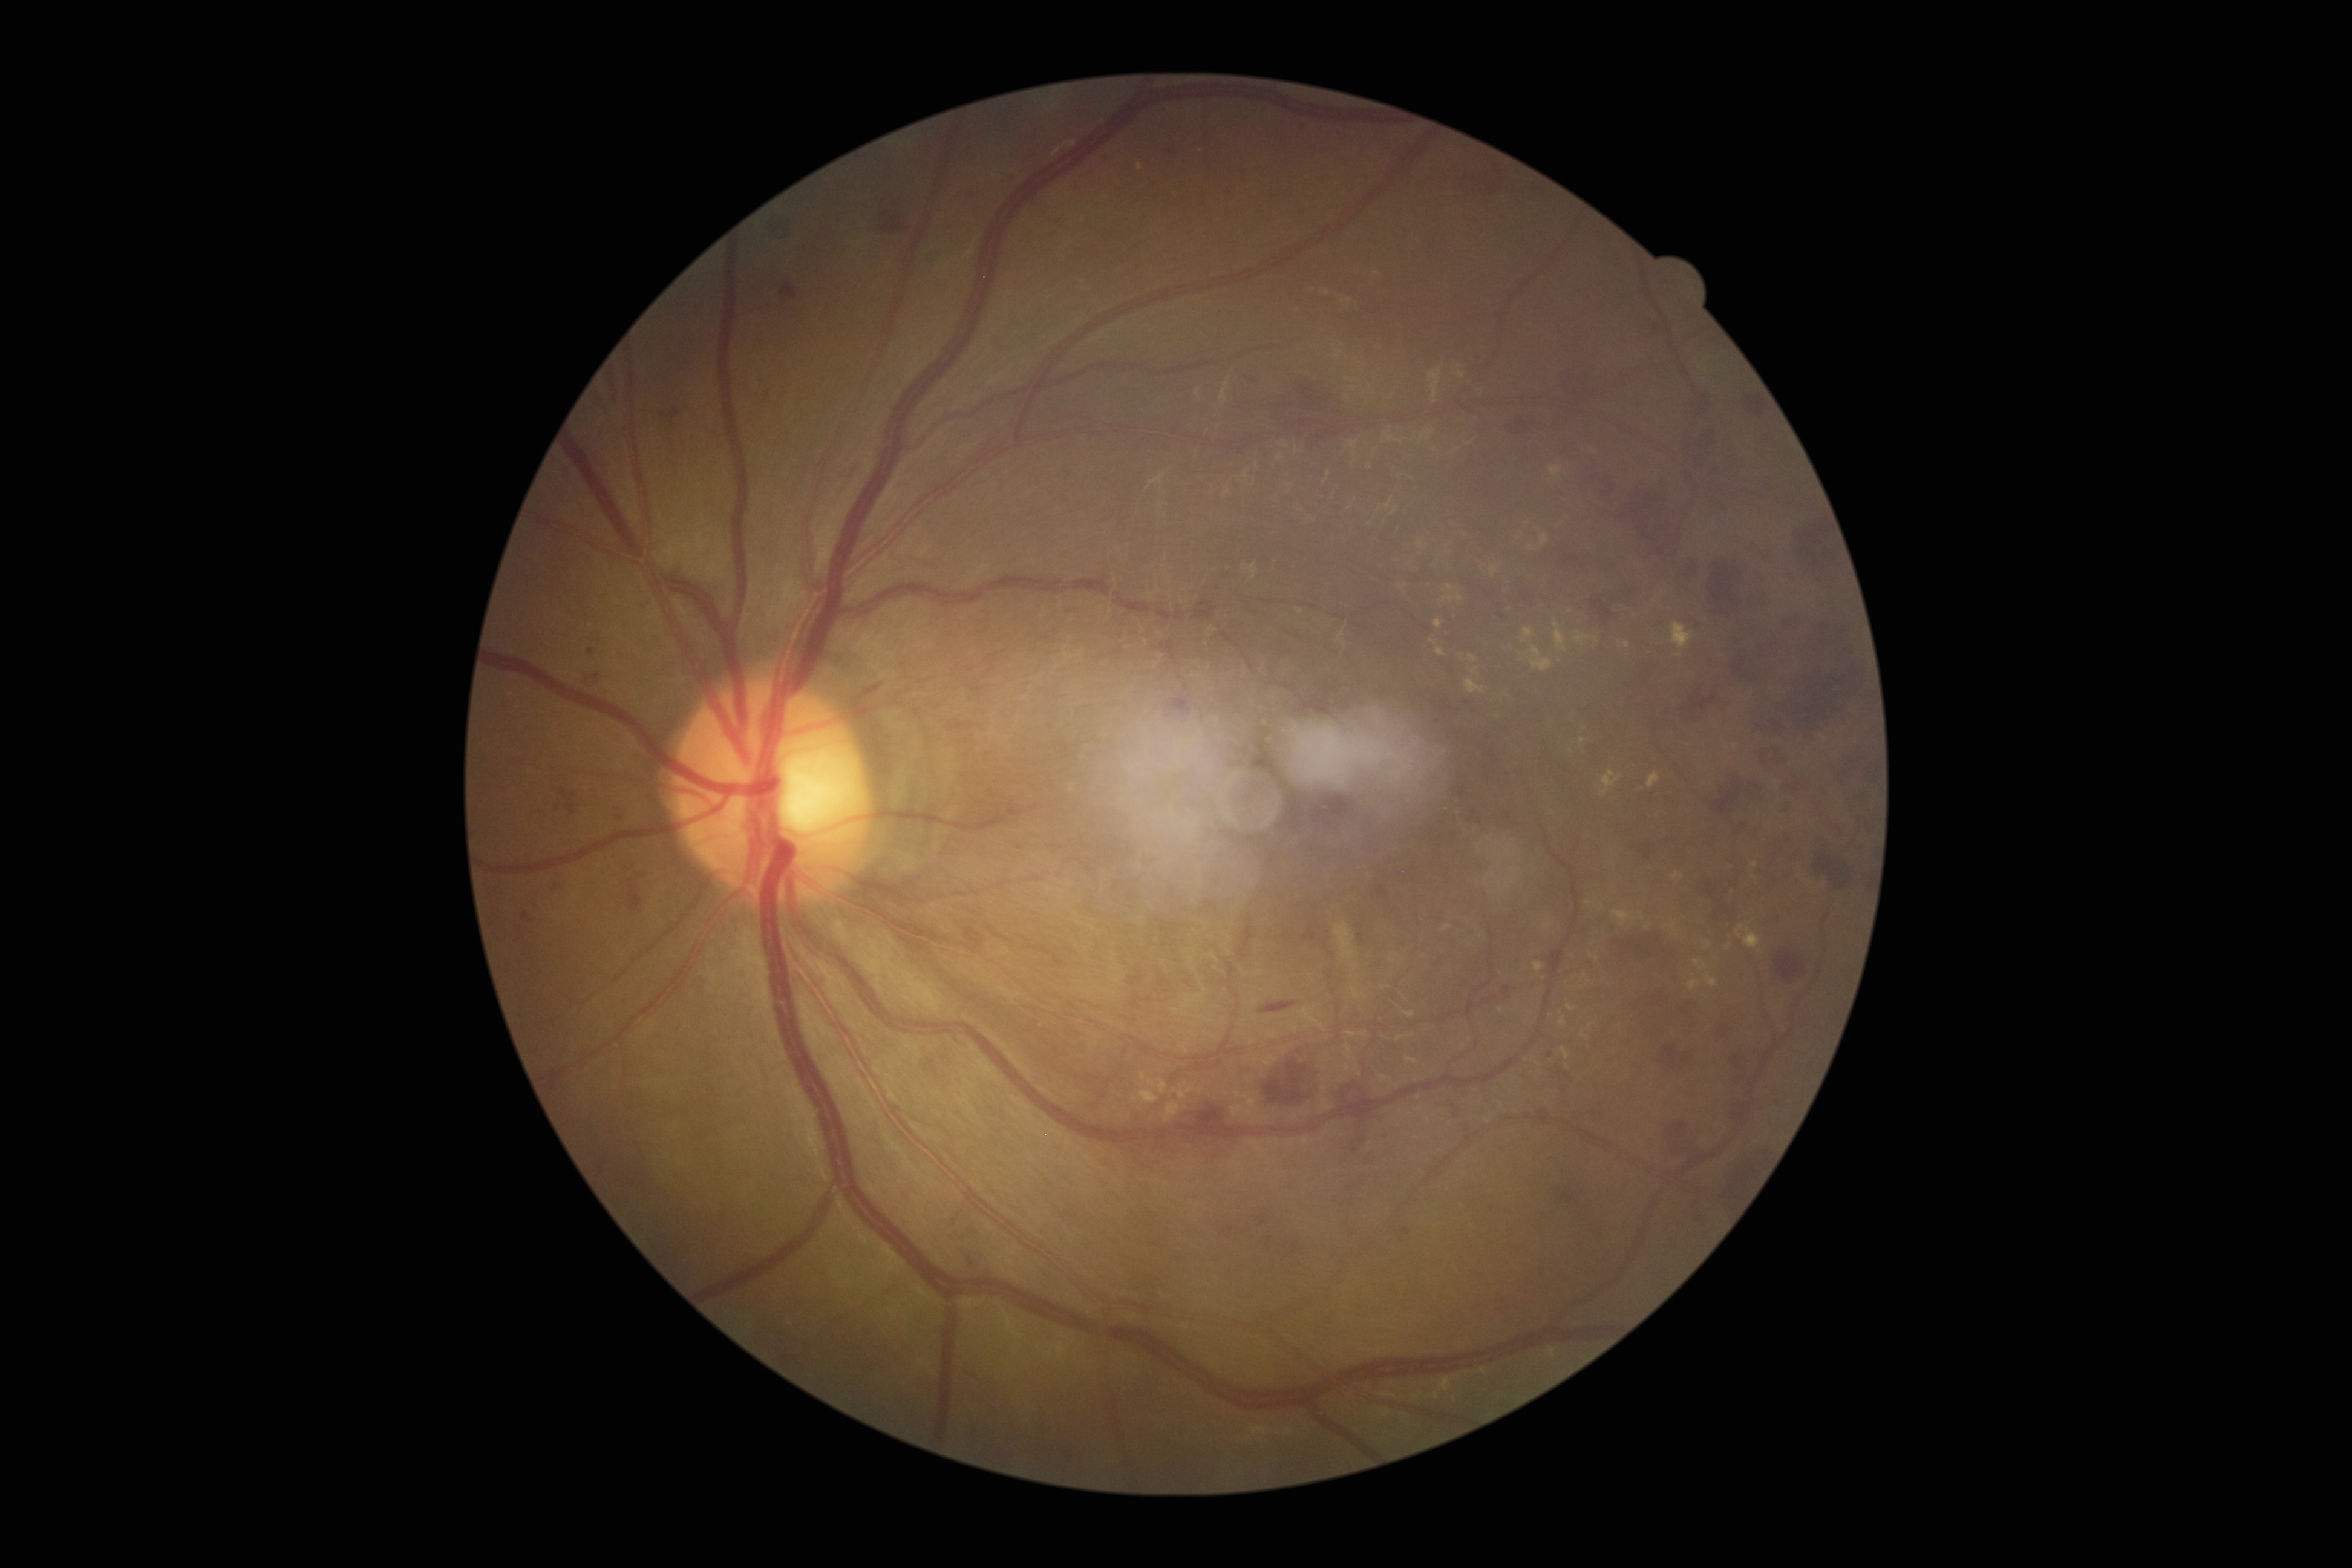
DR severity is grade 3 (severe NPDR).